848x848px: 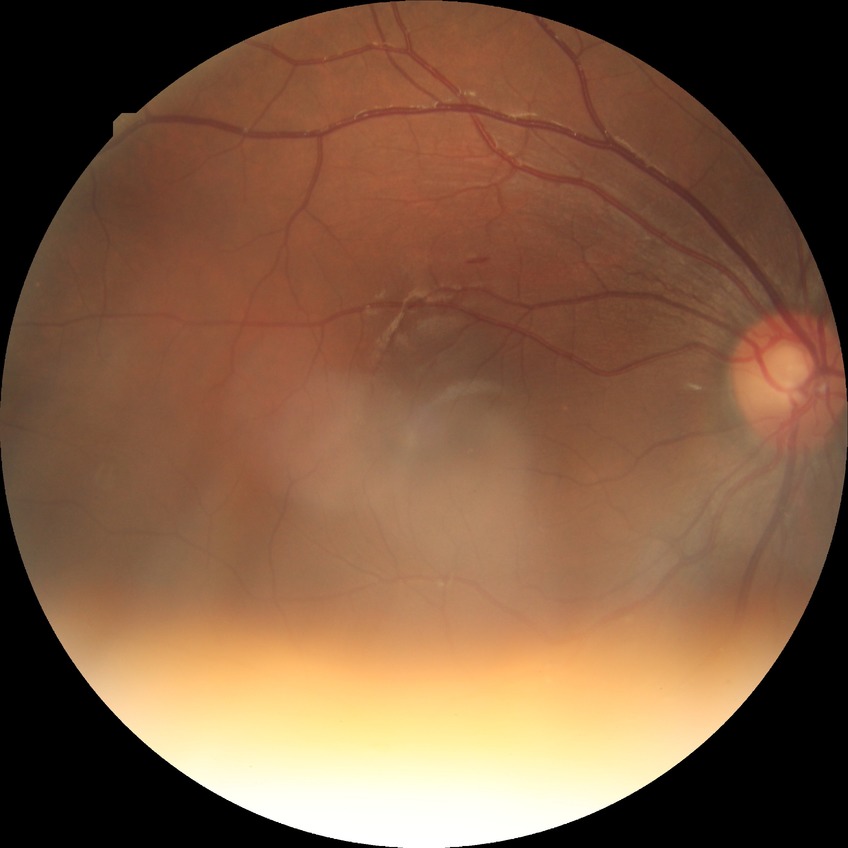
retinopathy grade = no diabetic retinopathy.